45-degree field of view.
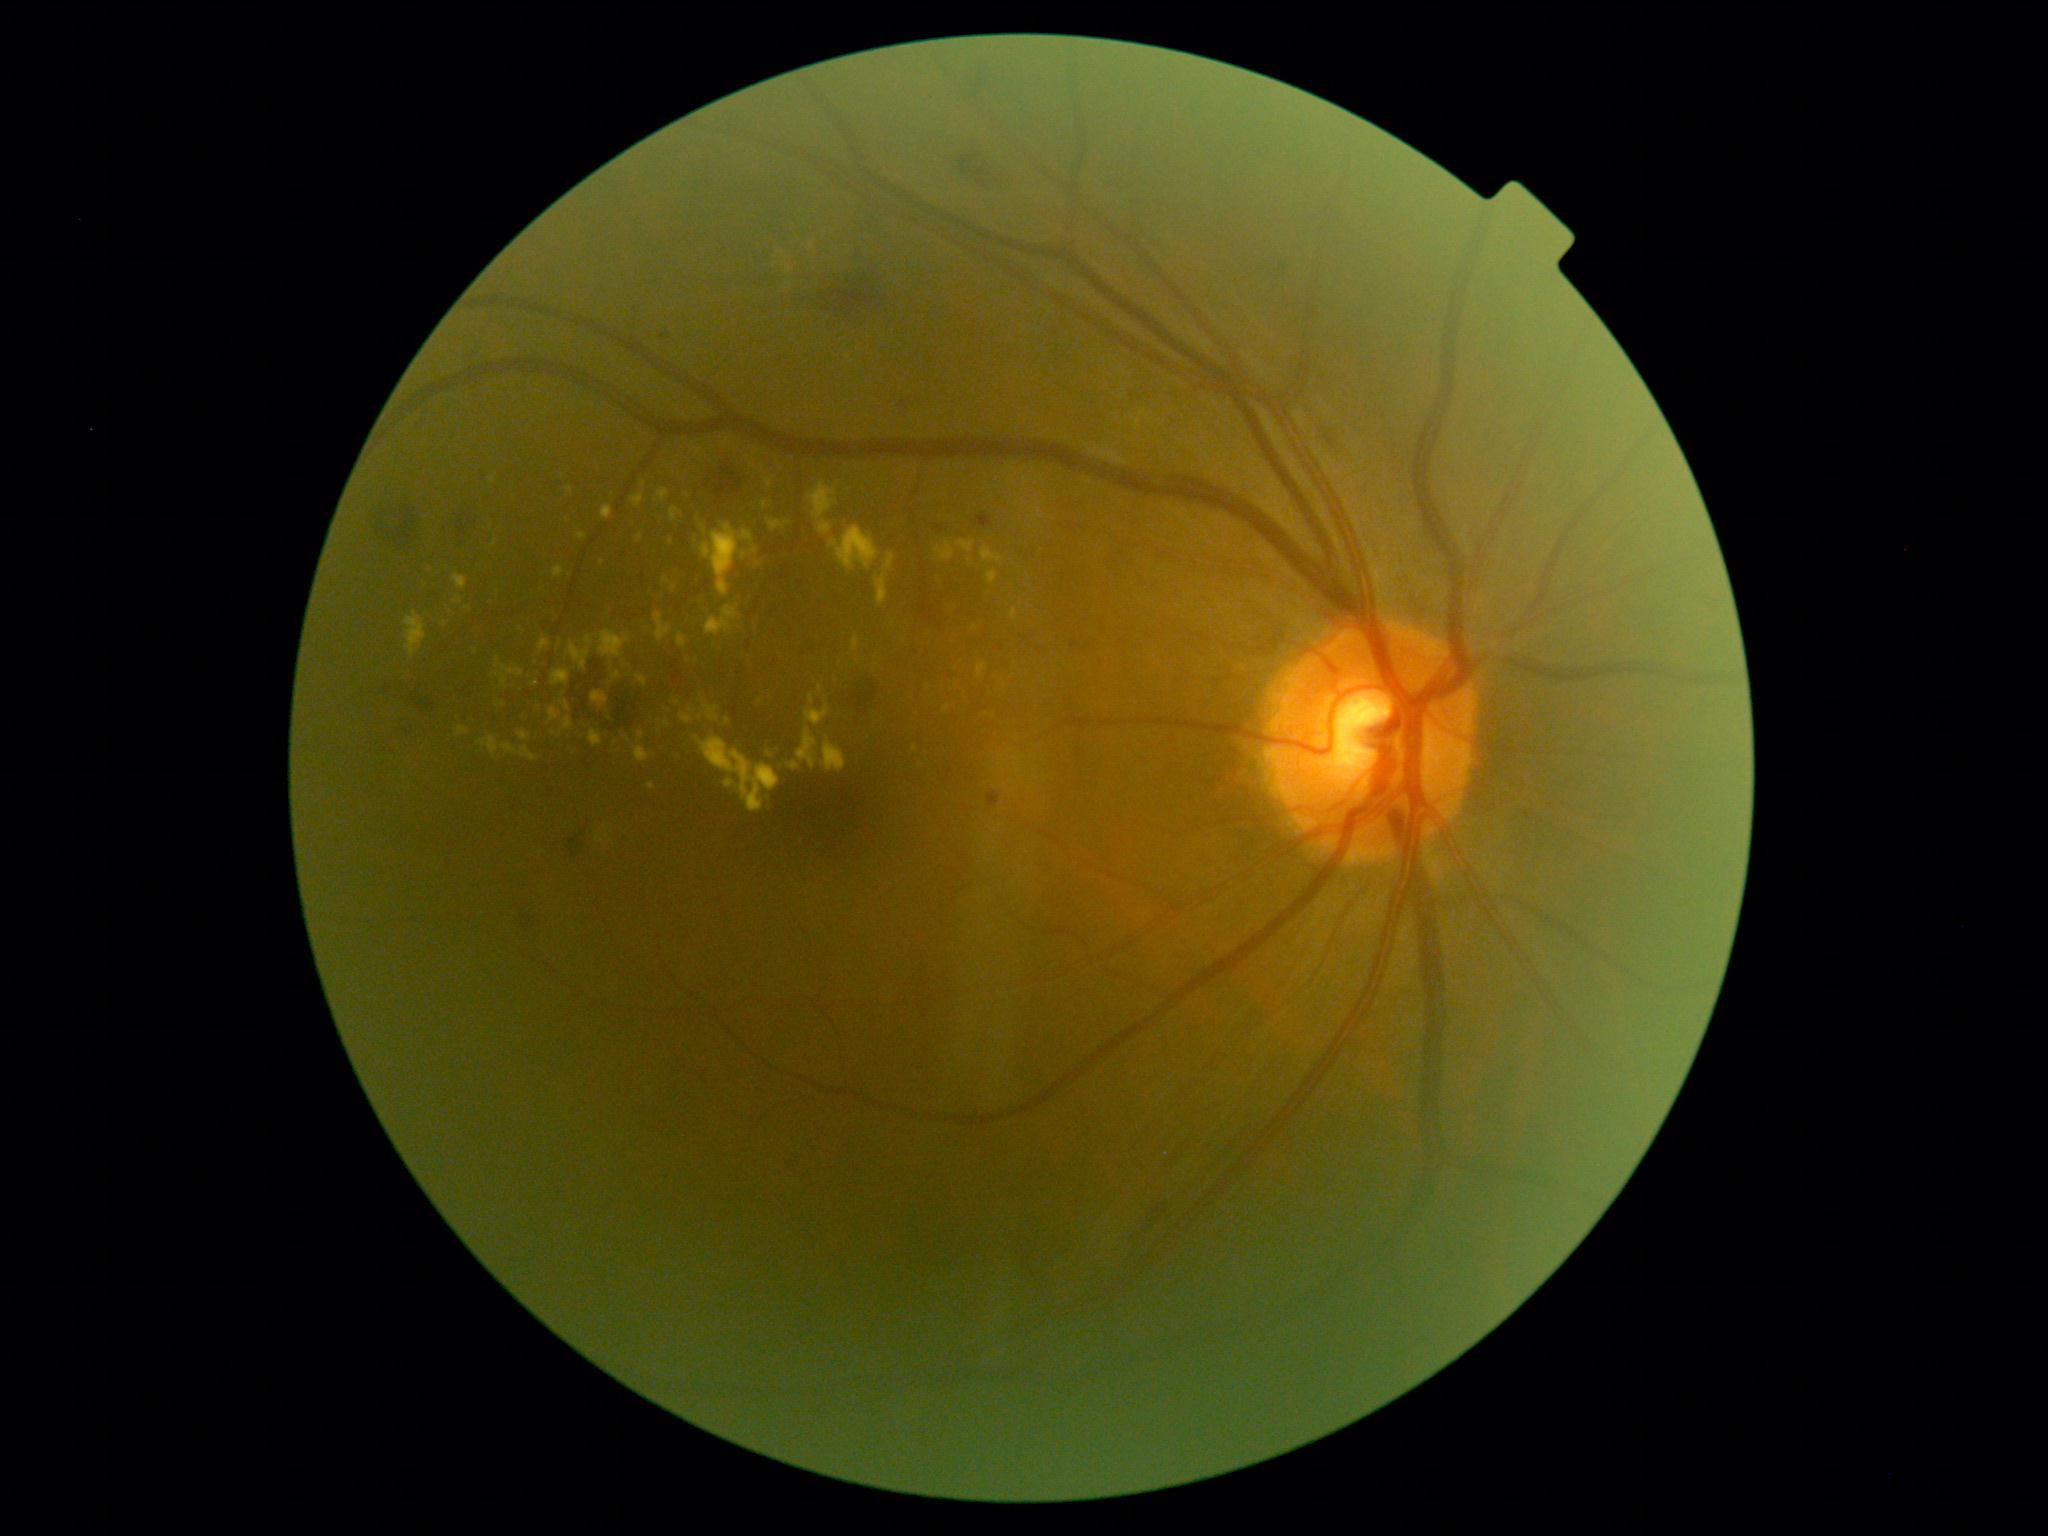

Diabetic retinopathy (DR) is grade 2 (moderate NPDR)
Selected lesions:
hard exudates (EXs) (partial): bbox=[455, 595, 463, 605], bbox=[935, 541, 956, 562], bbox=[539, 637, 550, 653], bbox=[705, 605, 742, 637], bbox=[552, 670, 570, 686], bbox=[560, 701, 572, 713], bbox=[978, 663, 986, 680], bbox=[613, 673, 620, 681], bbox=[599, 630, 632, 658], bbox=[498, 703, 506, 707], bbox=[589, 730, 603, 747]
Additional small EXs near point(643, 485), point(521, 629), point(1013, 470), point(758, 563), point(915, 749), point(431, 568)